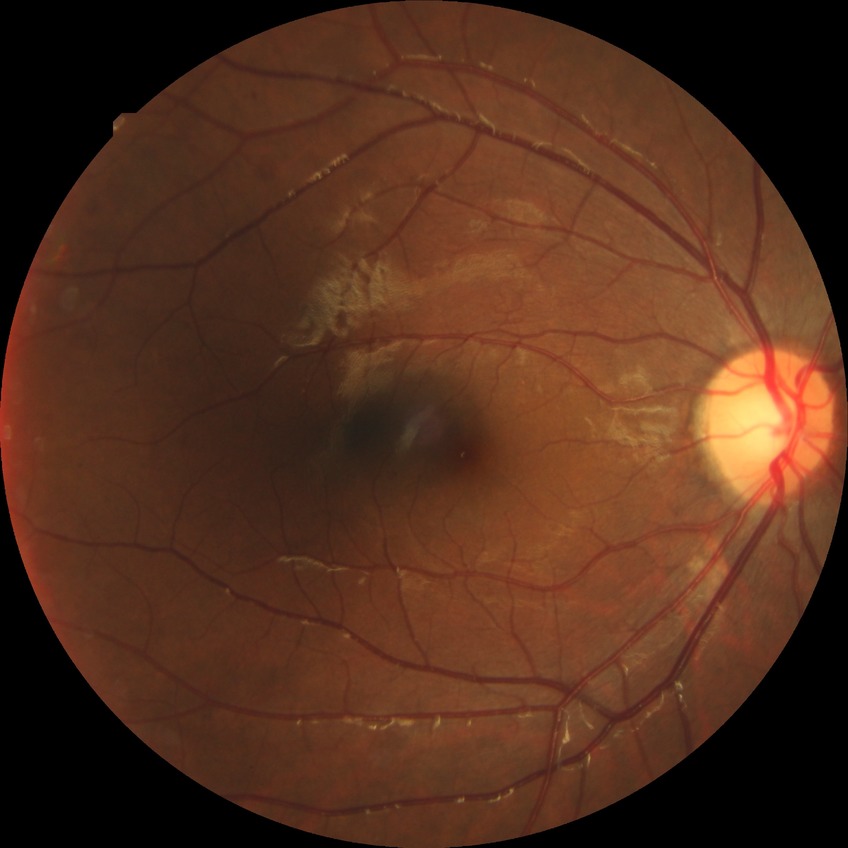

  davis_grade: SDR (simple diabetic retinopathy)
  proliferative_class: non-proliferative diabetic retinopathy